Handheld portable fundus camera image
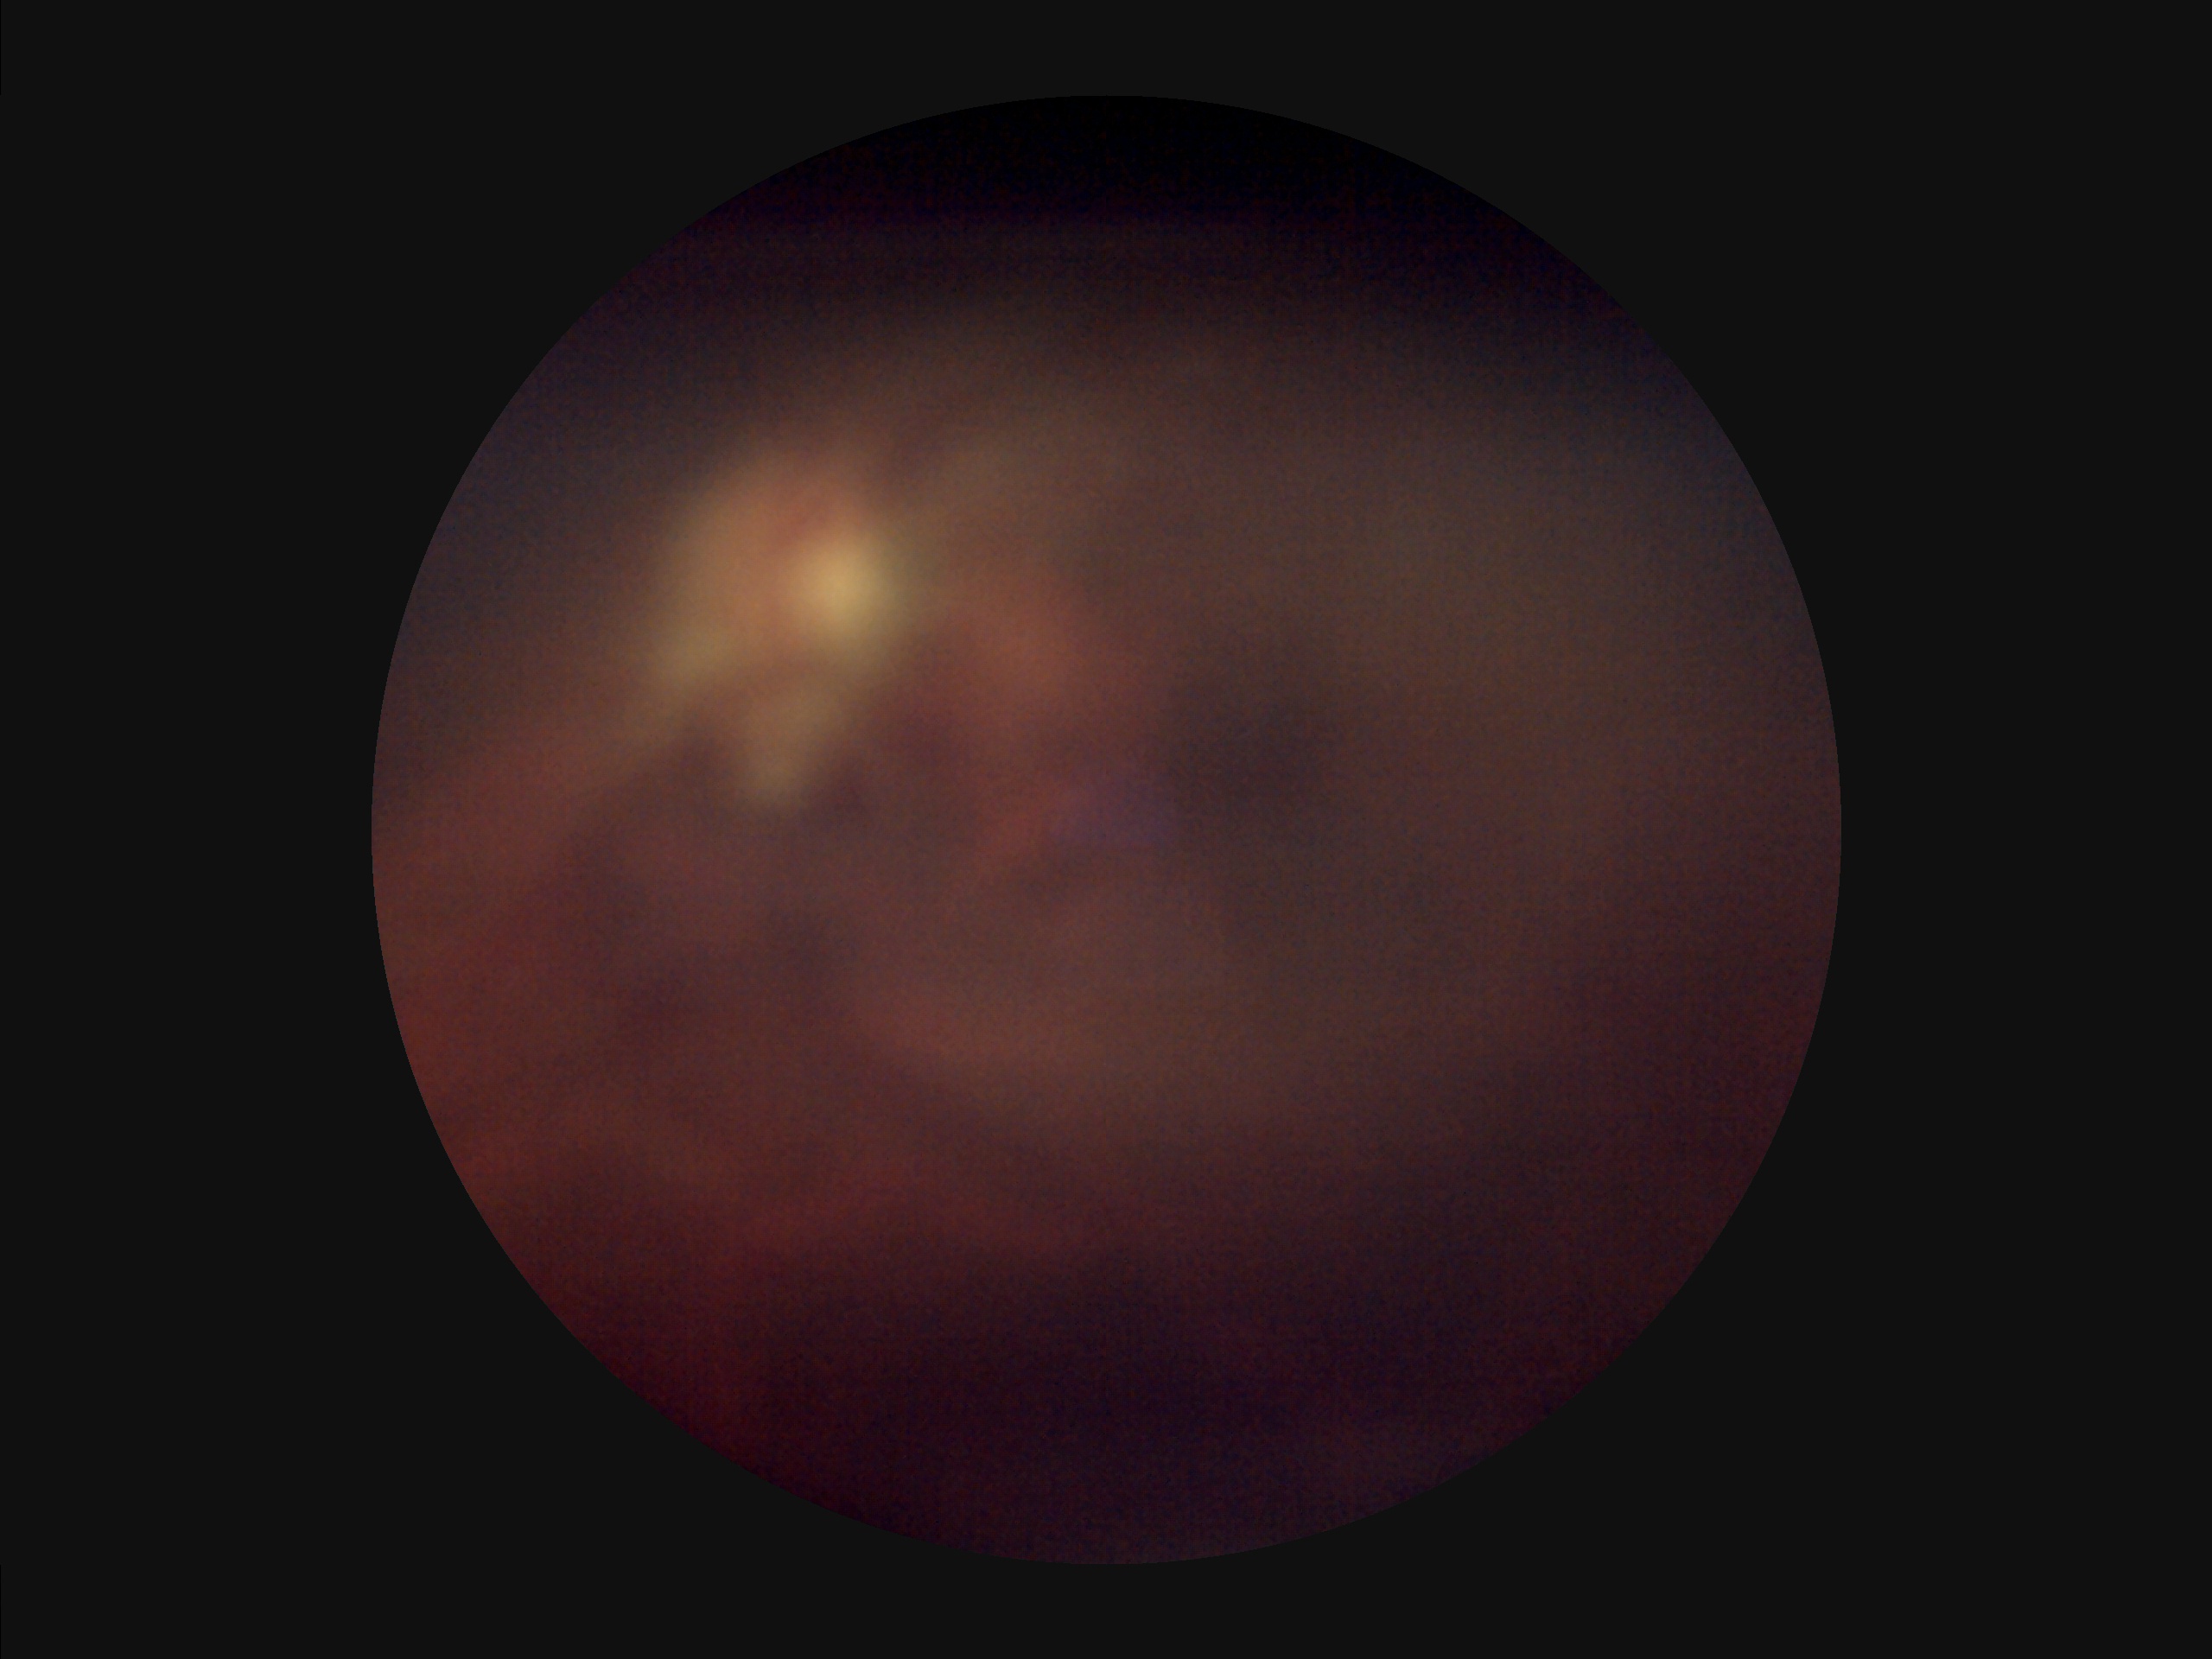 Image quality is suboptimal.
Poor dynamic range.
The image is blurry.
There is over- or under-exposure or a color cast.